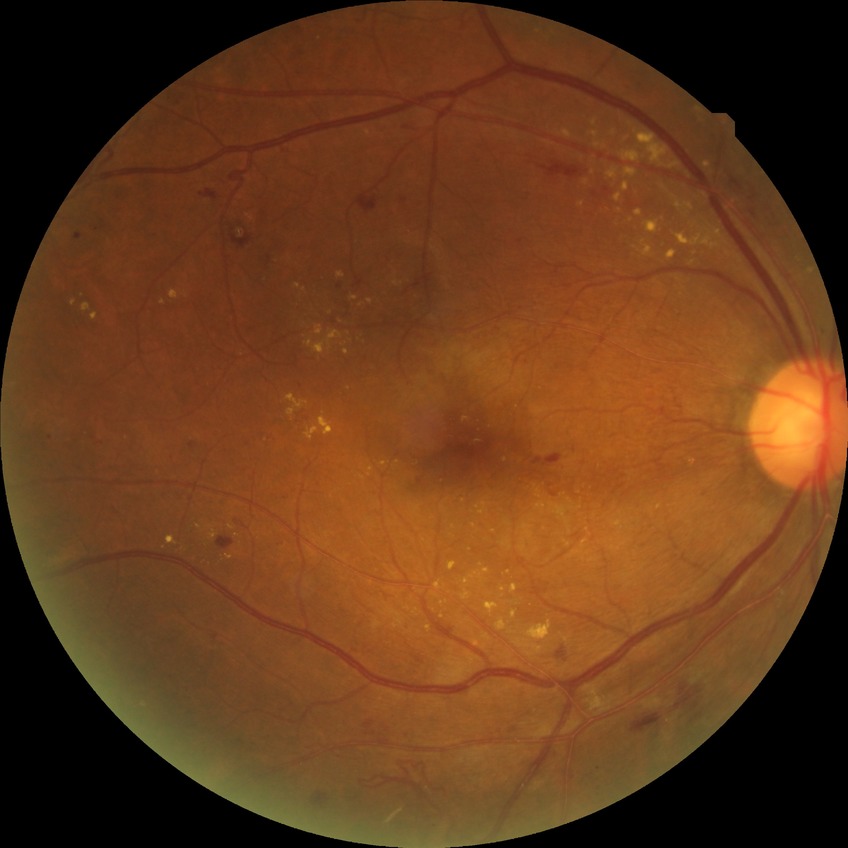   davis_grade: PPDR (pre-proliferative diabetic retinopathy)